IOP 14 mmHg (non-contact tonometry). Central corneal thickness: 526 µm. Autorefraction: sphere +3.75 D, cylinder +2 D, axis 7°. Non-mydriatic. Camera: Topcon TRC-NW400.
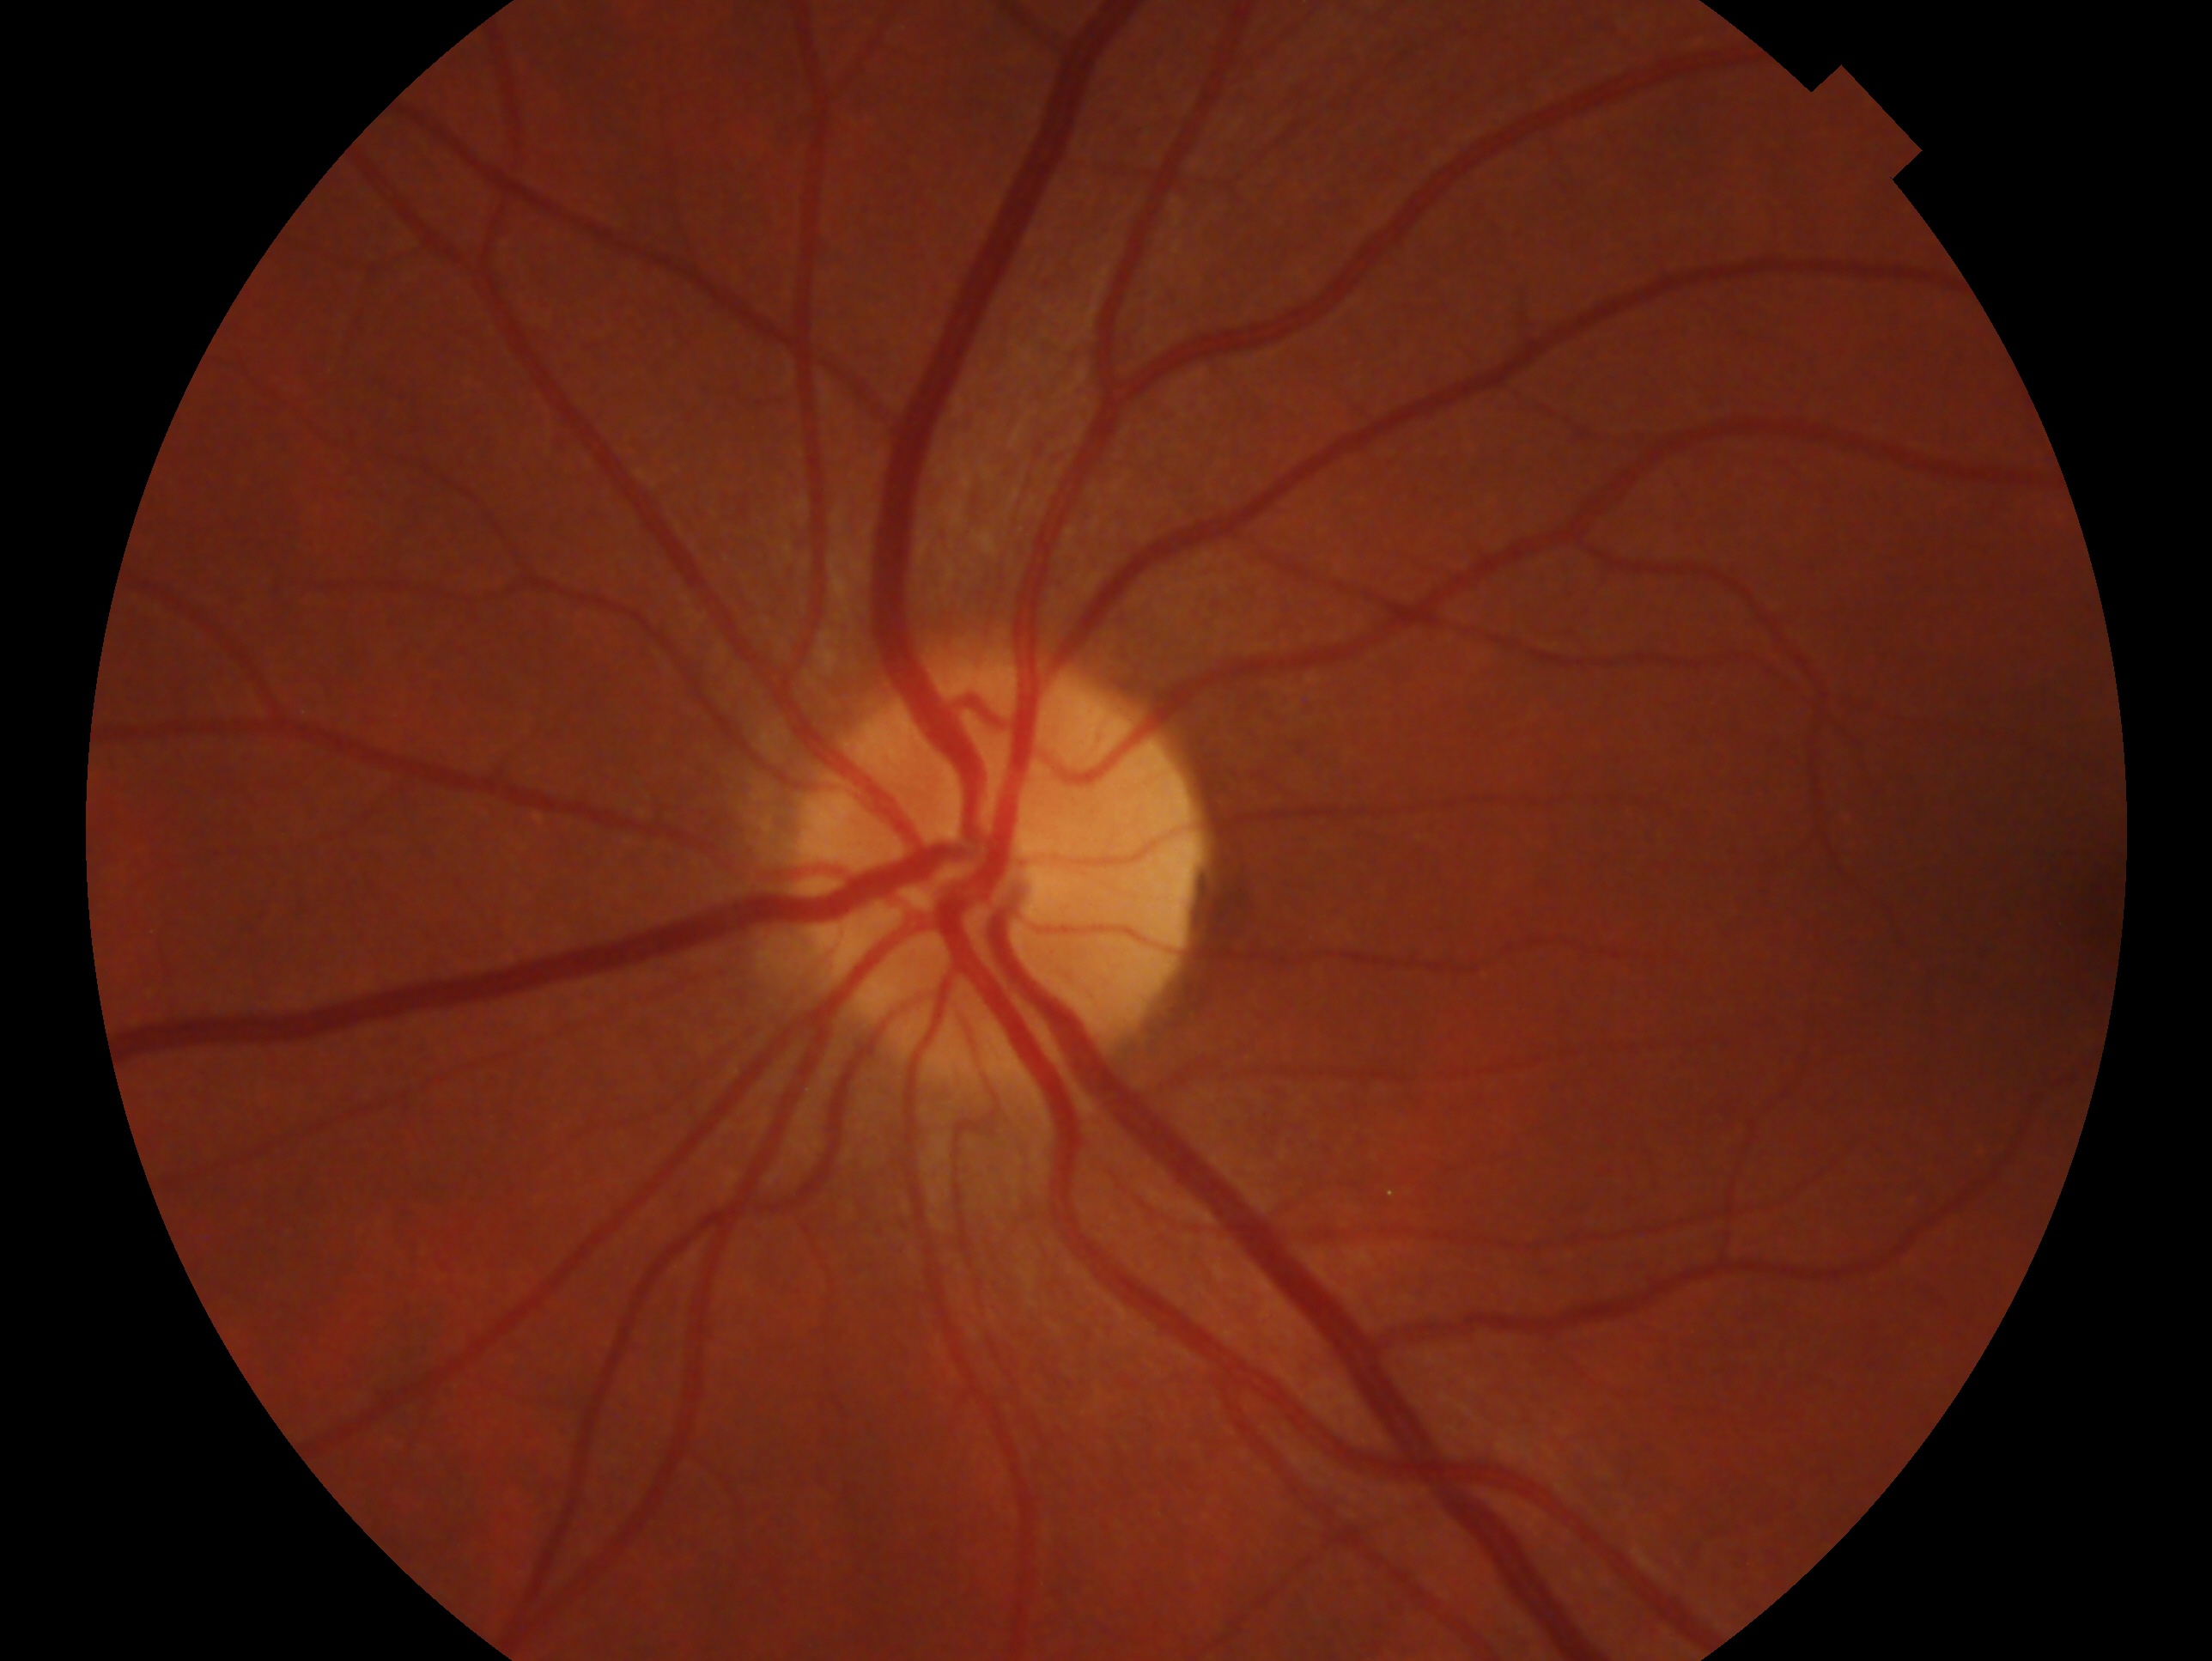 Annotations:
* clinical classification: no signs of glaucoma
* eye: OS